Modified Davis grading; retinal fundus photograph; acquired with a NIDEK AFC-230.
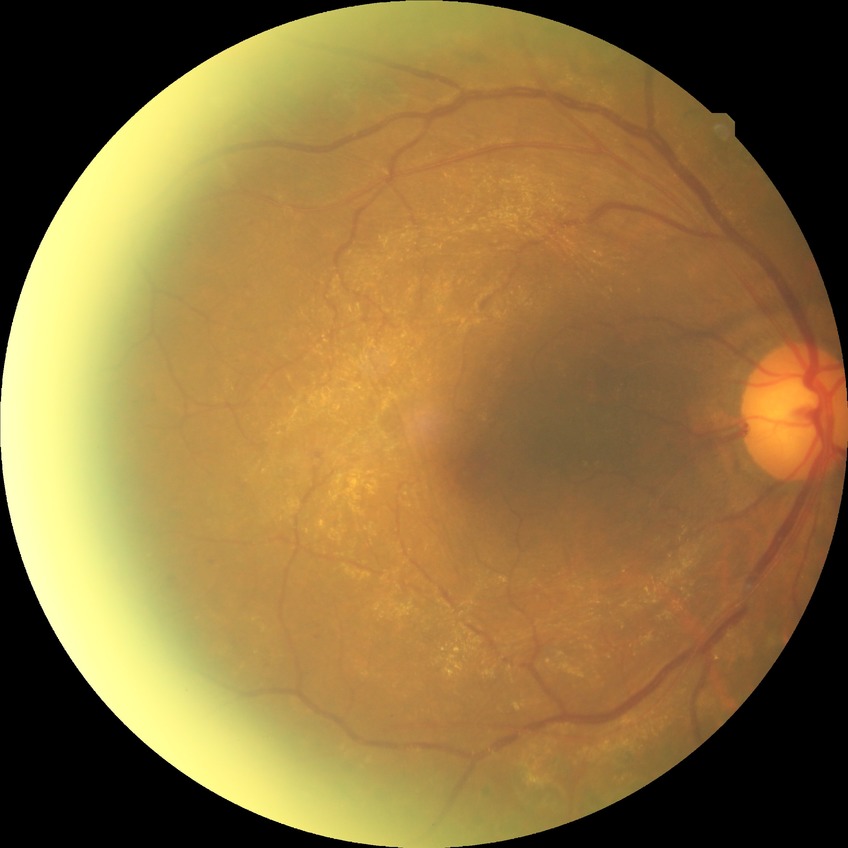 diabetic retinopathy severity=proliferative diabetic retinopathy.